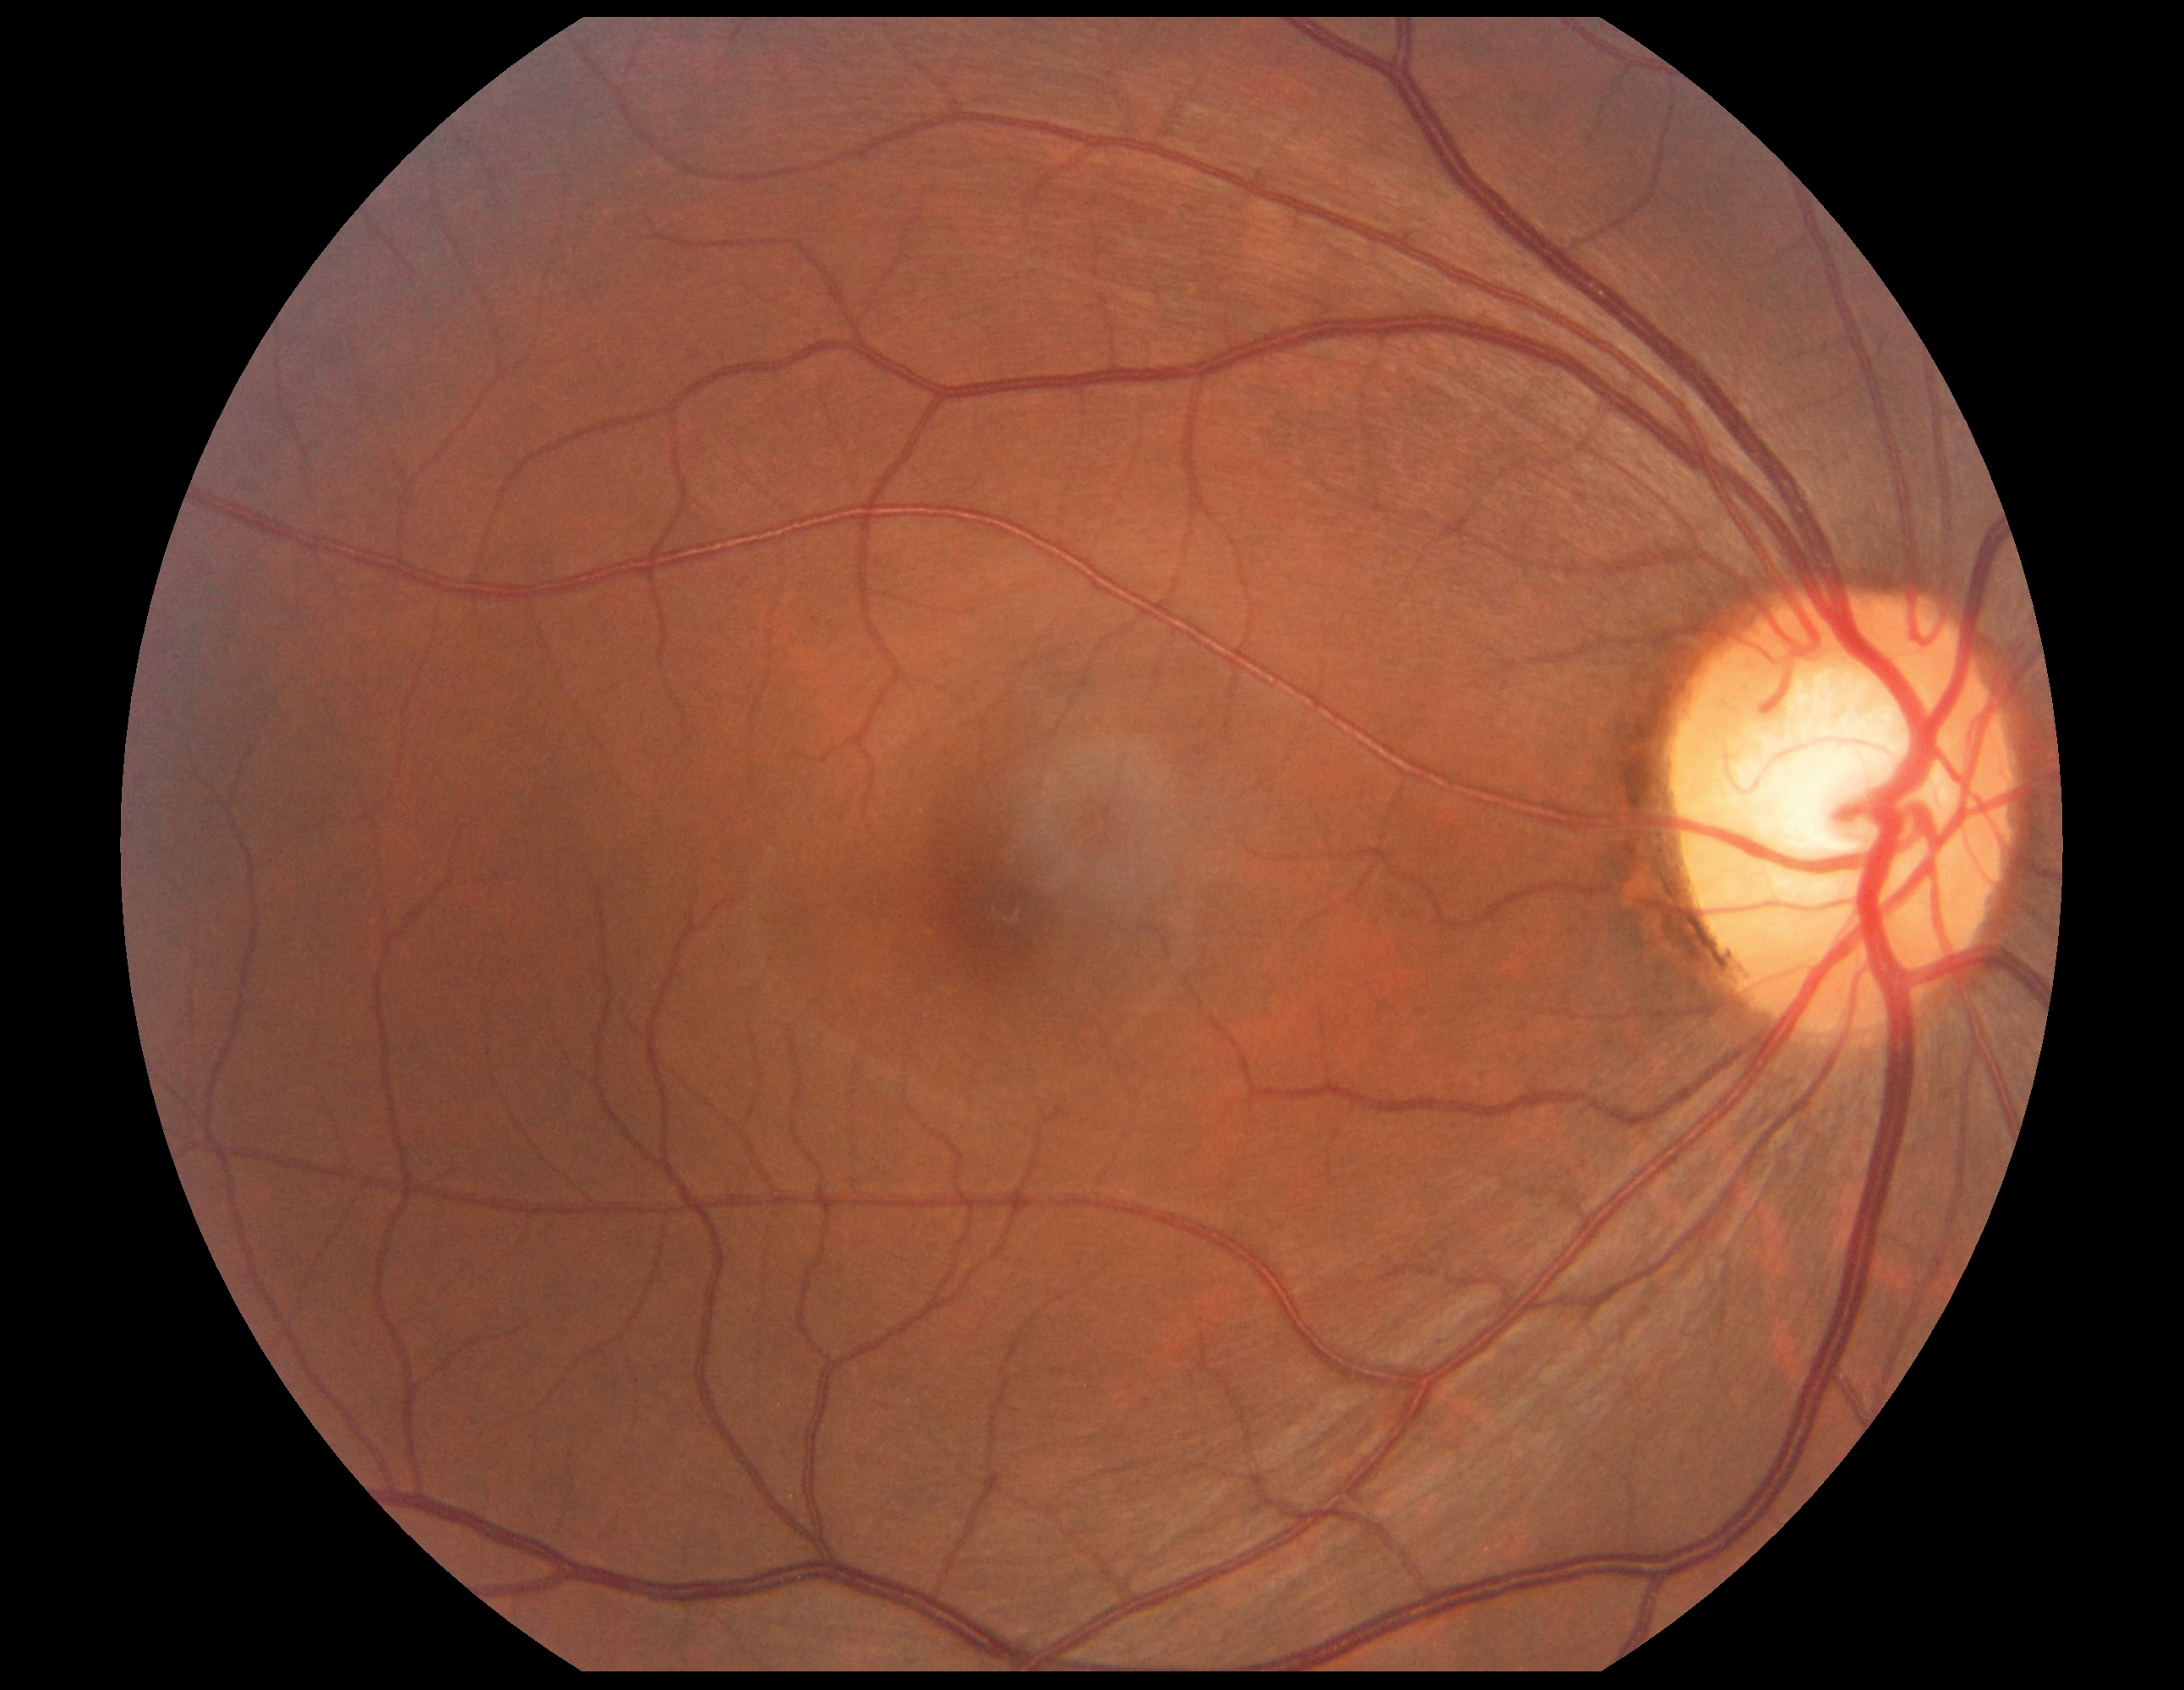

Findings:
* diabetic retinopathy grade: no apparent diabetic retinopathy (0)
* DR impression: no DR findings